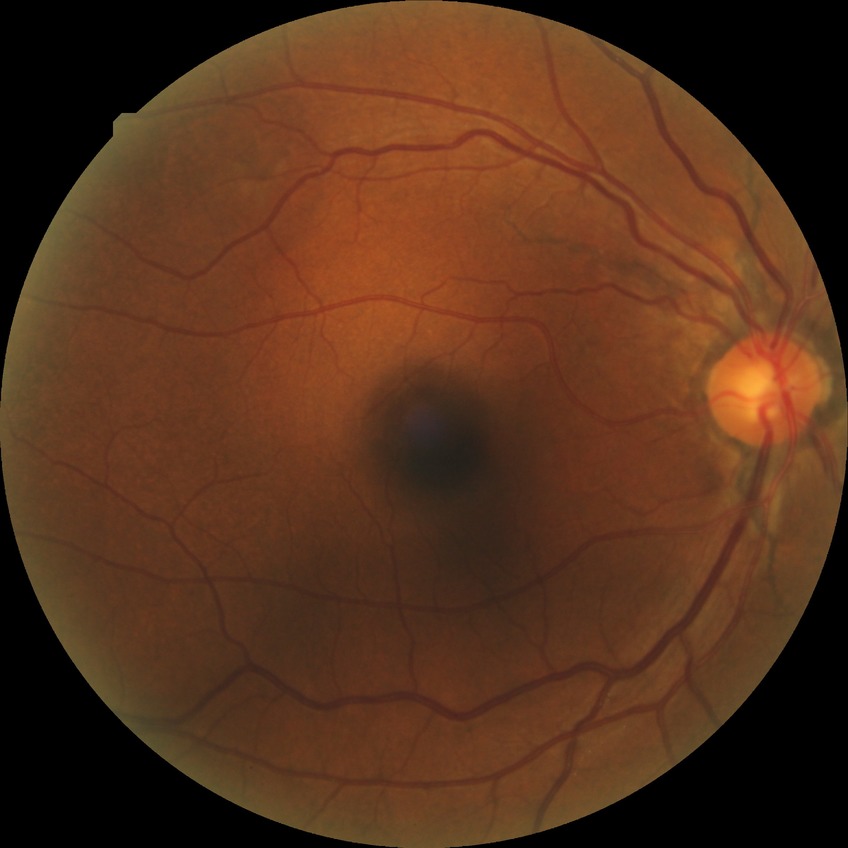

Diabetic retinopathy (DR): no diabetic retinopathy (NDR).